2184x1690px; fundus photo: 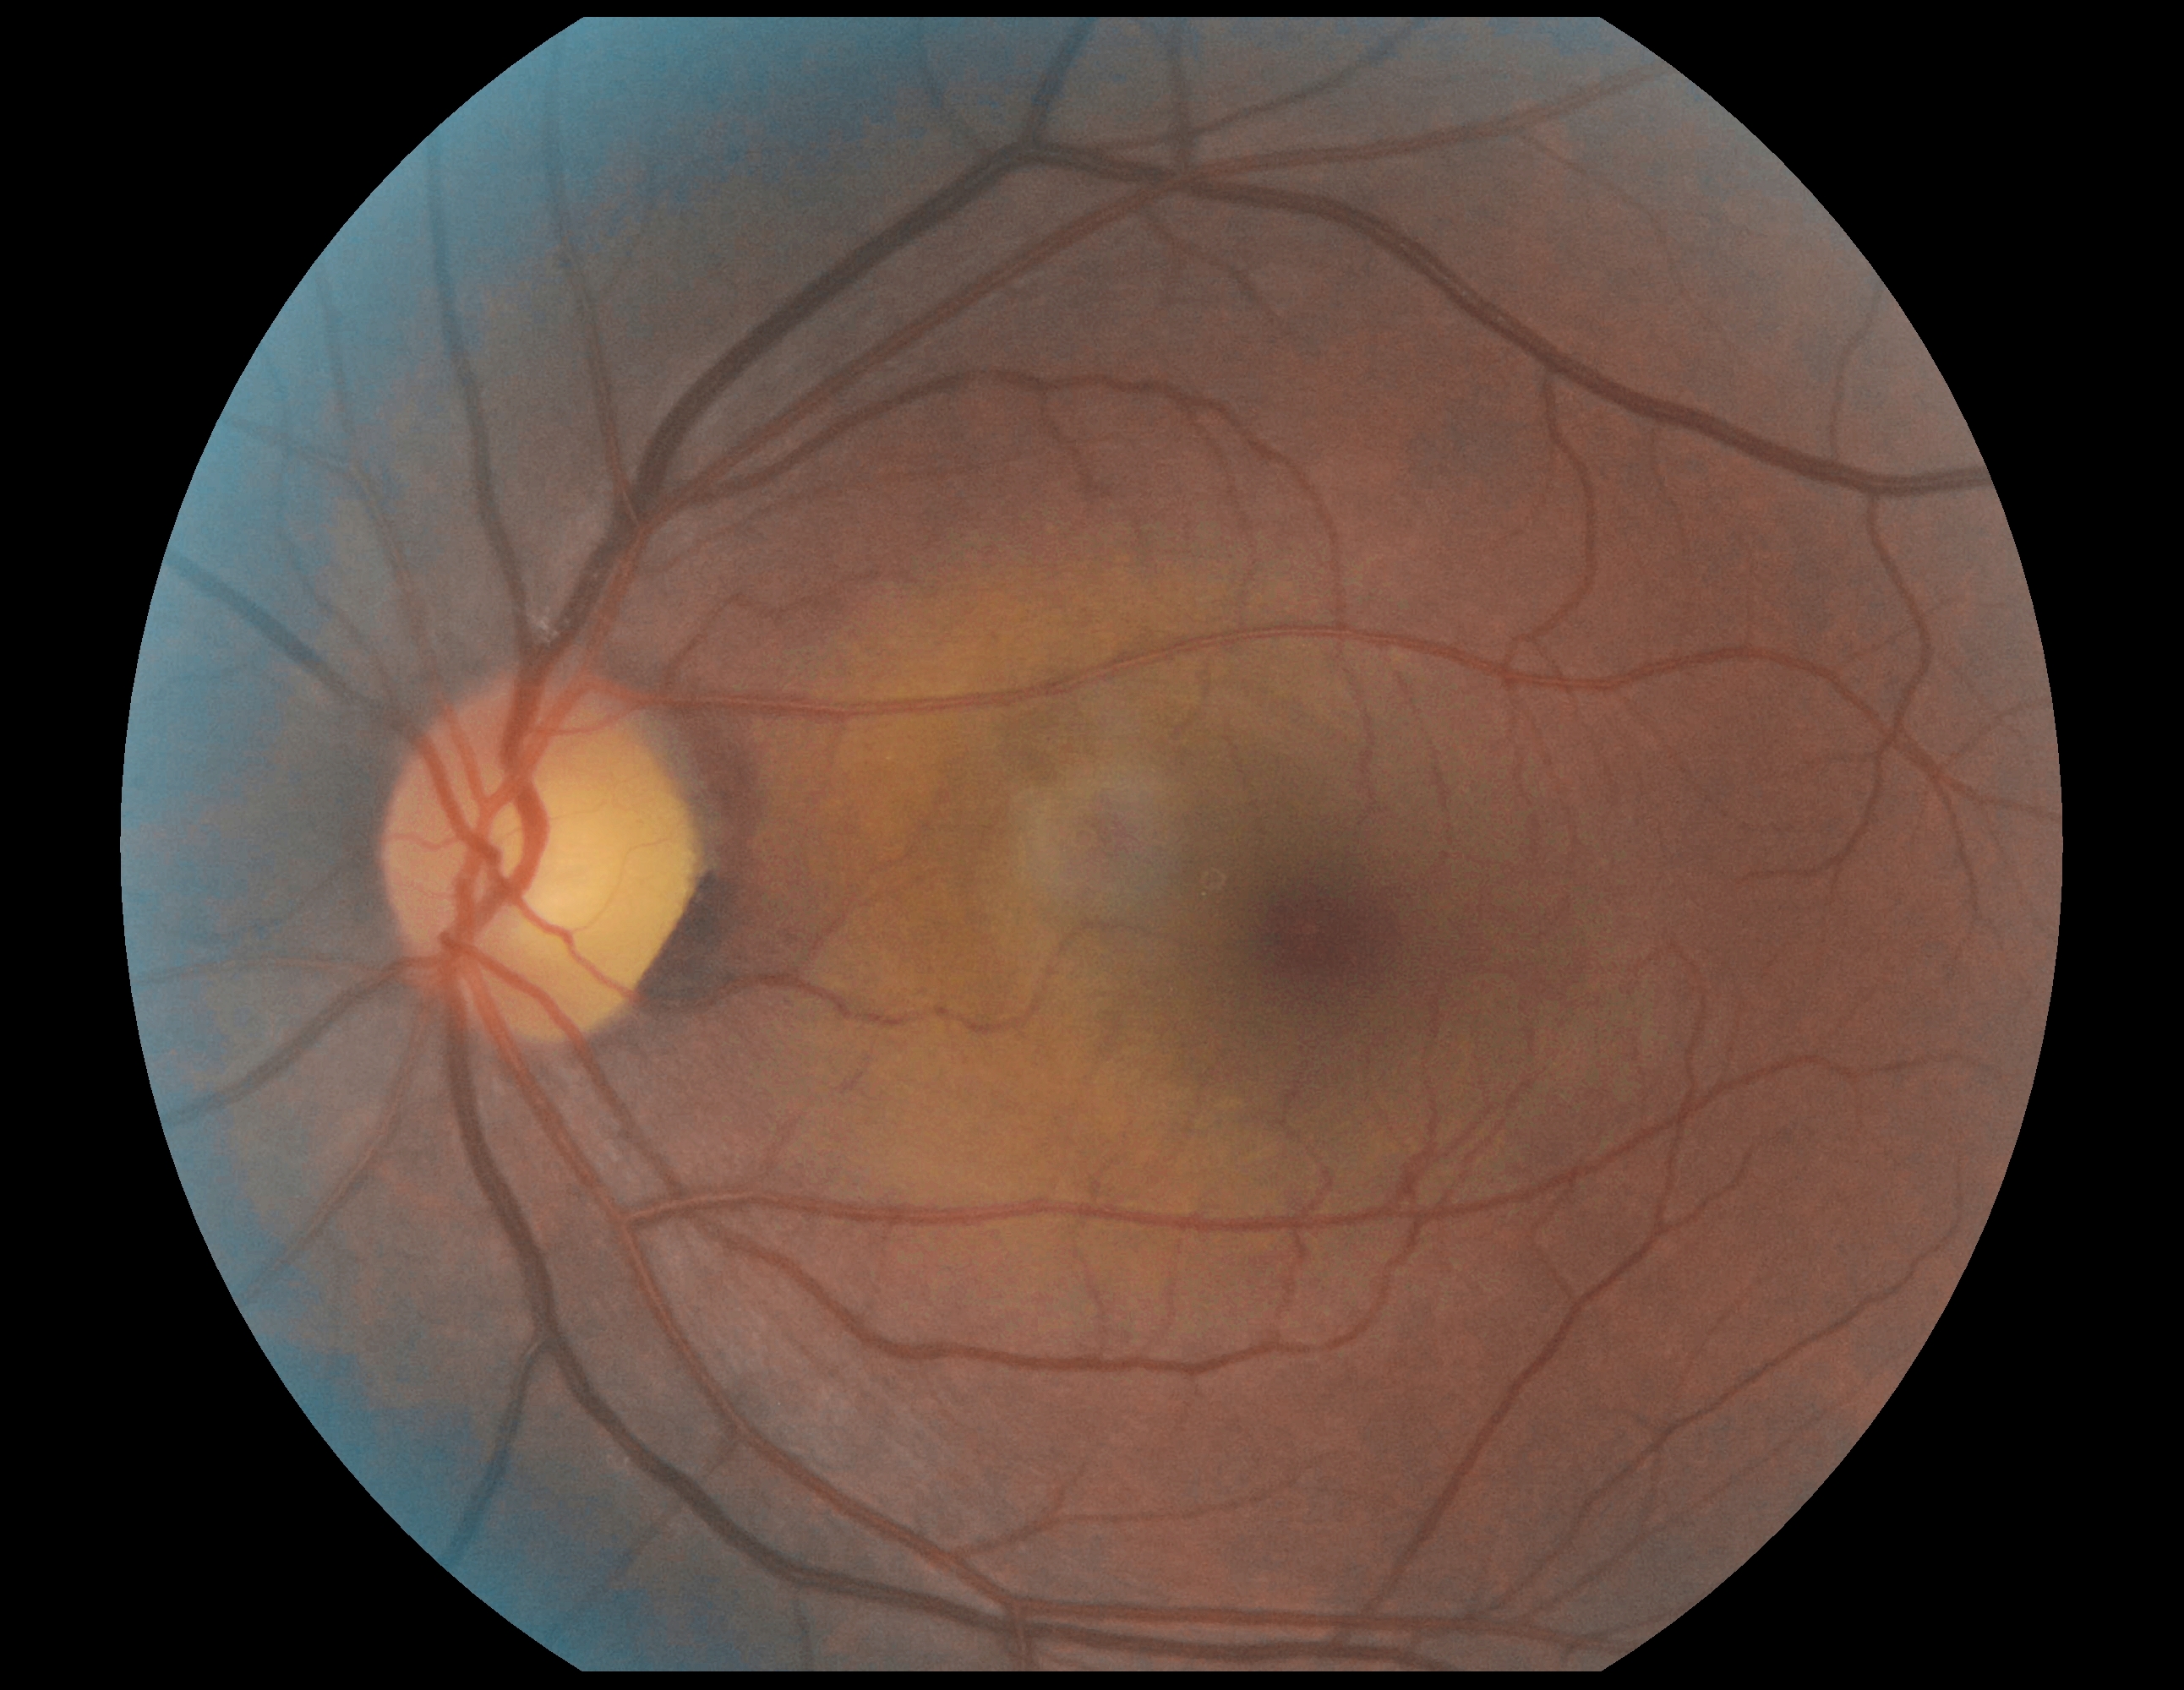

DR severity is 0/4 — no visible signs of diabetic retinopathy. No diabetic retinal disease findings.